Pediatric retinal photograph (wide-field) · 1440x1080px.
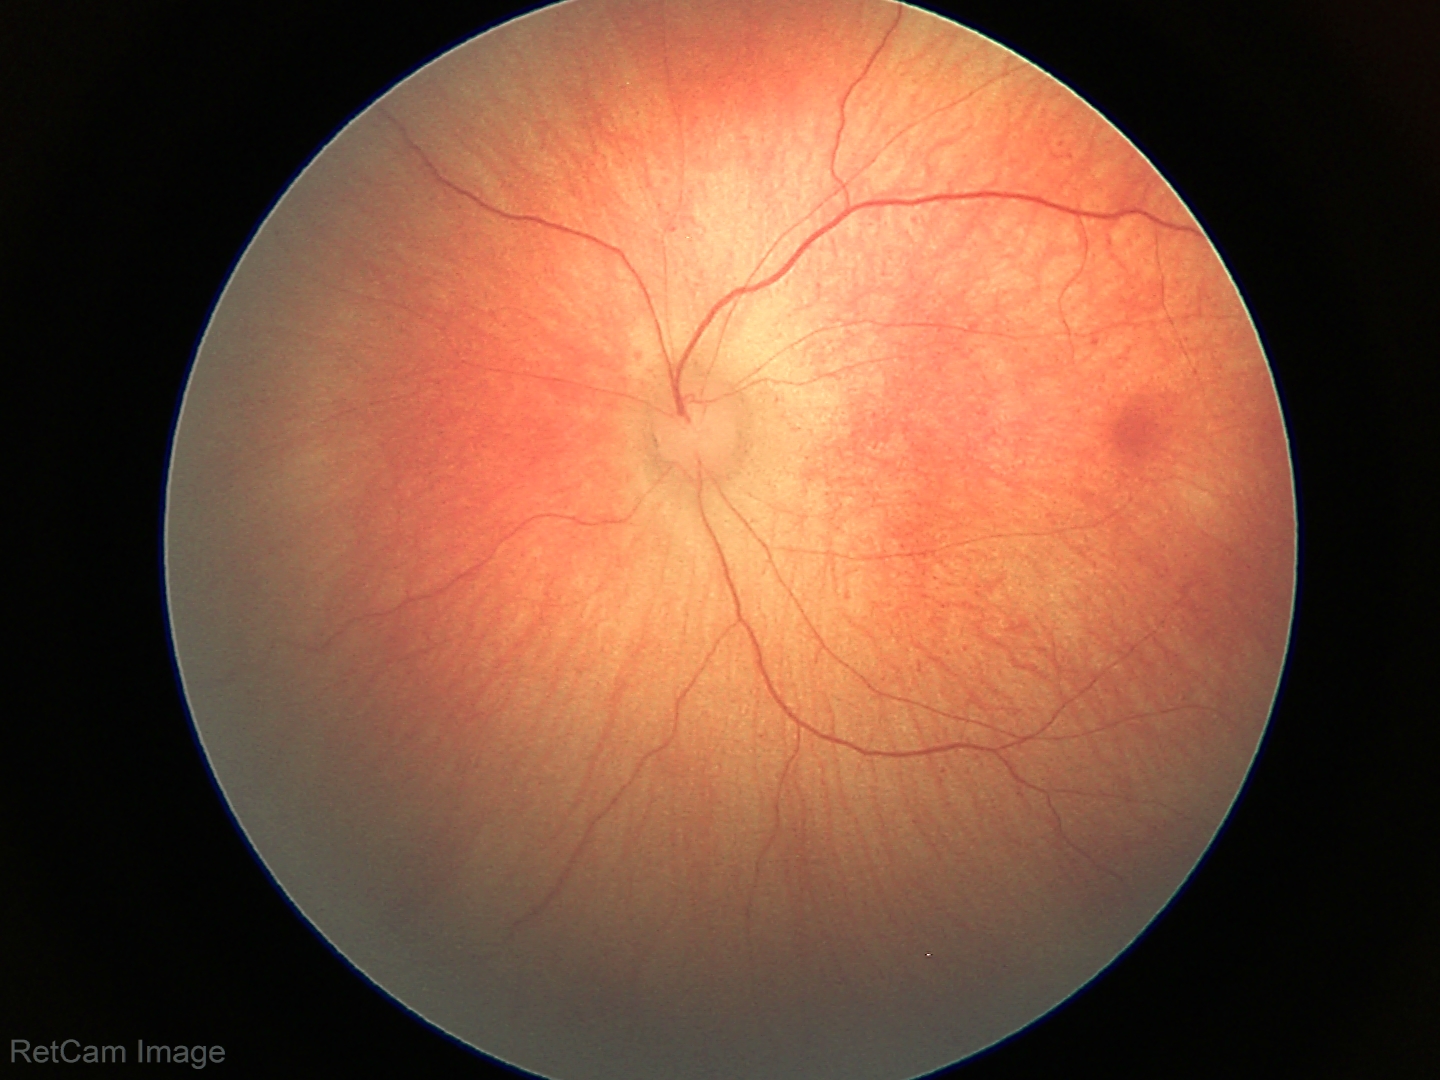
Screening examination consistent with retinal hemorrhages.